FOV: 45 degrees, retinal fundus photograph: 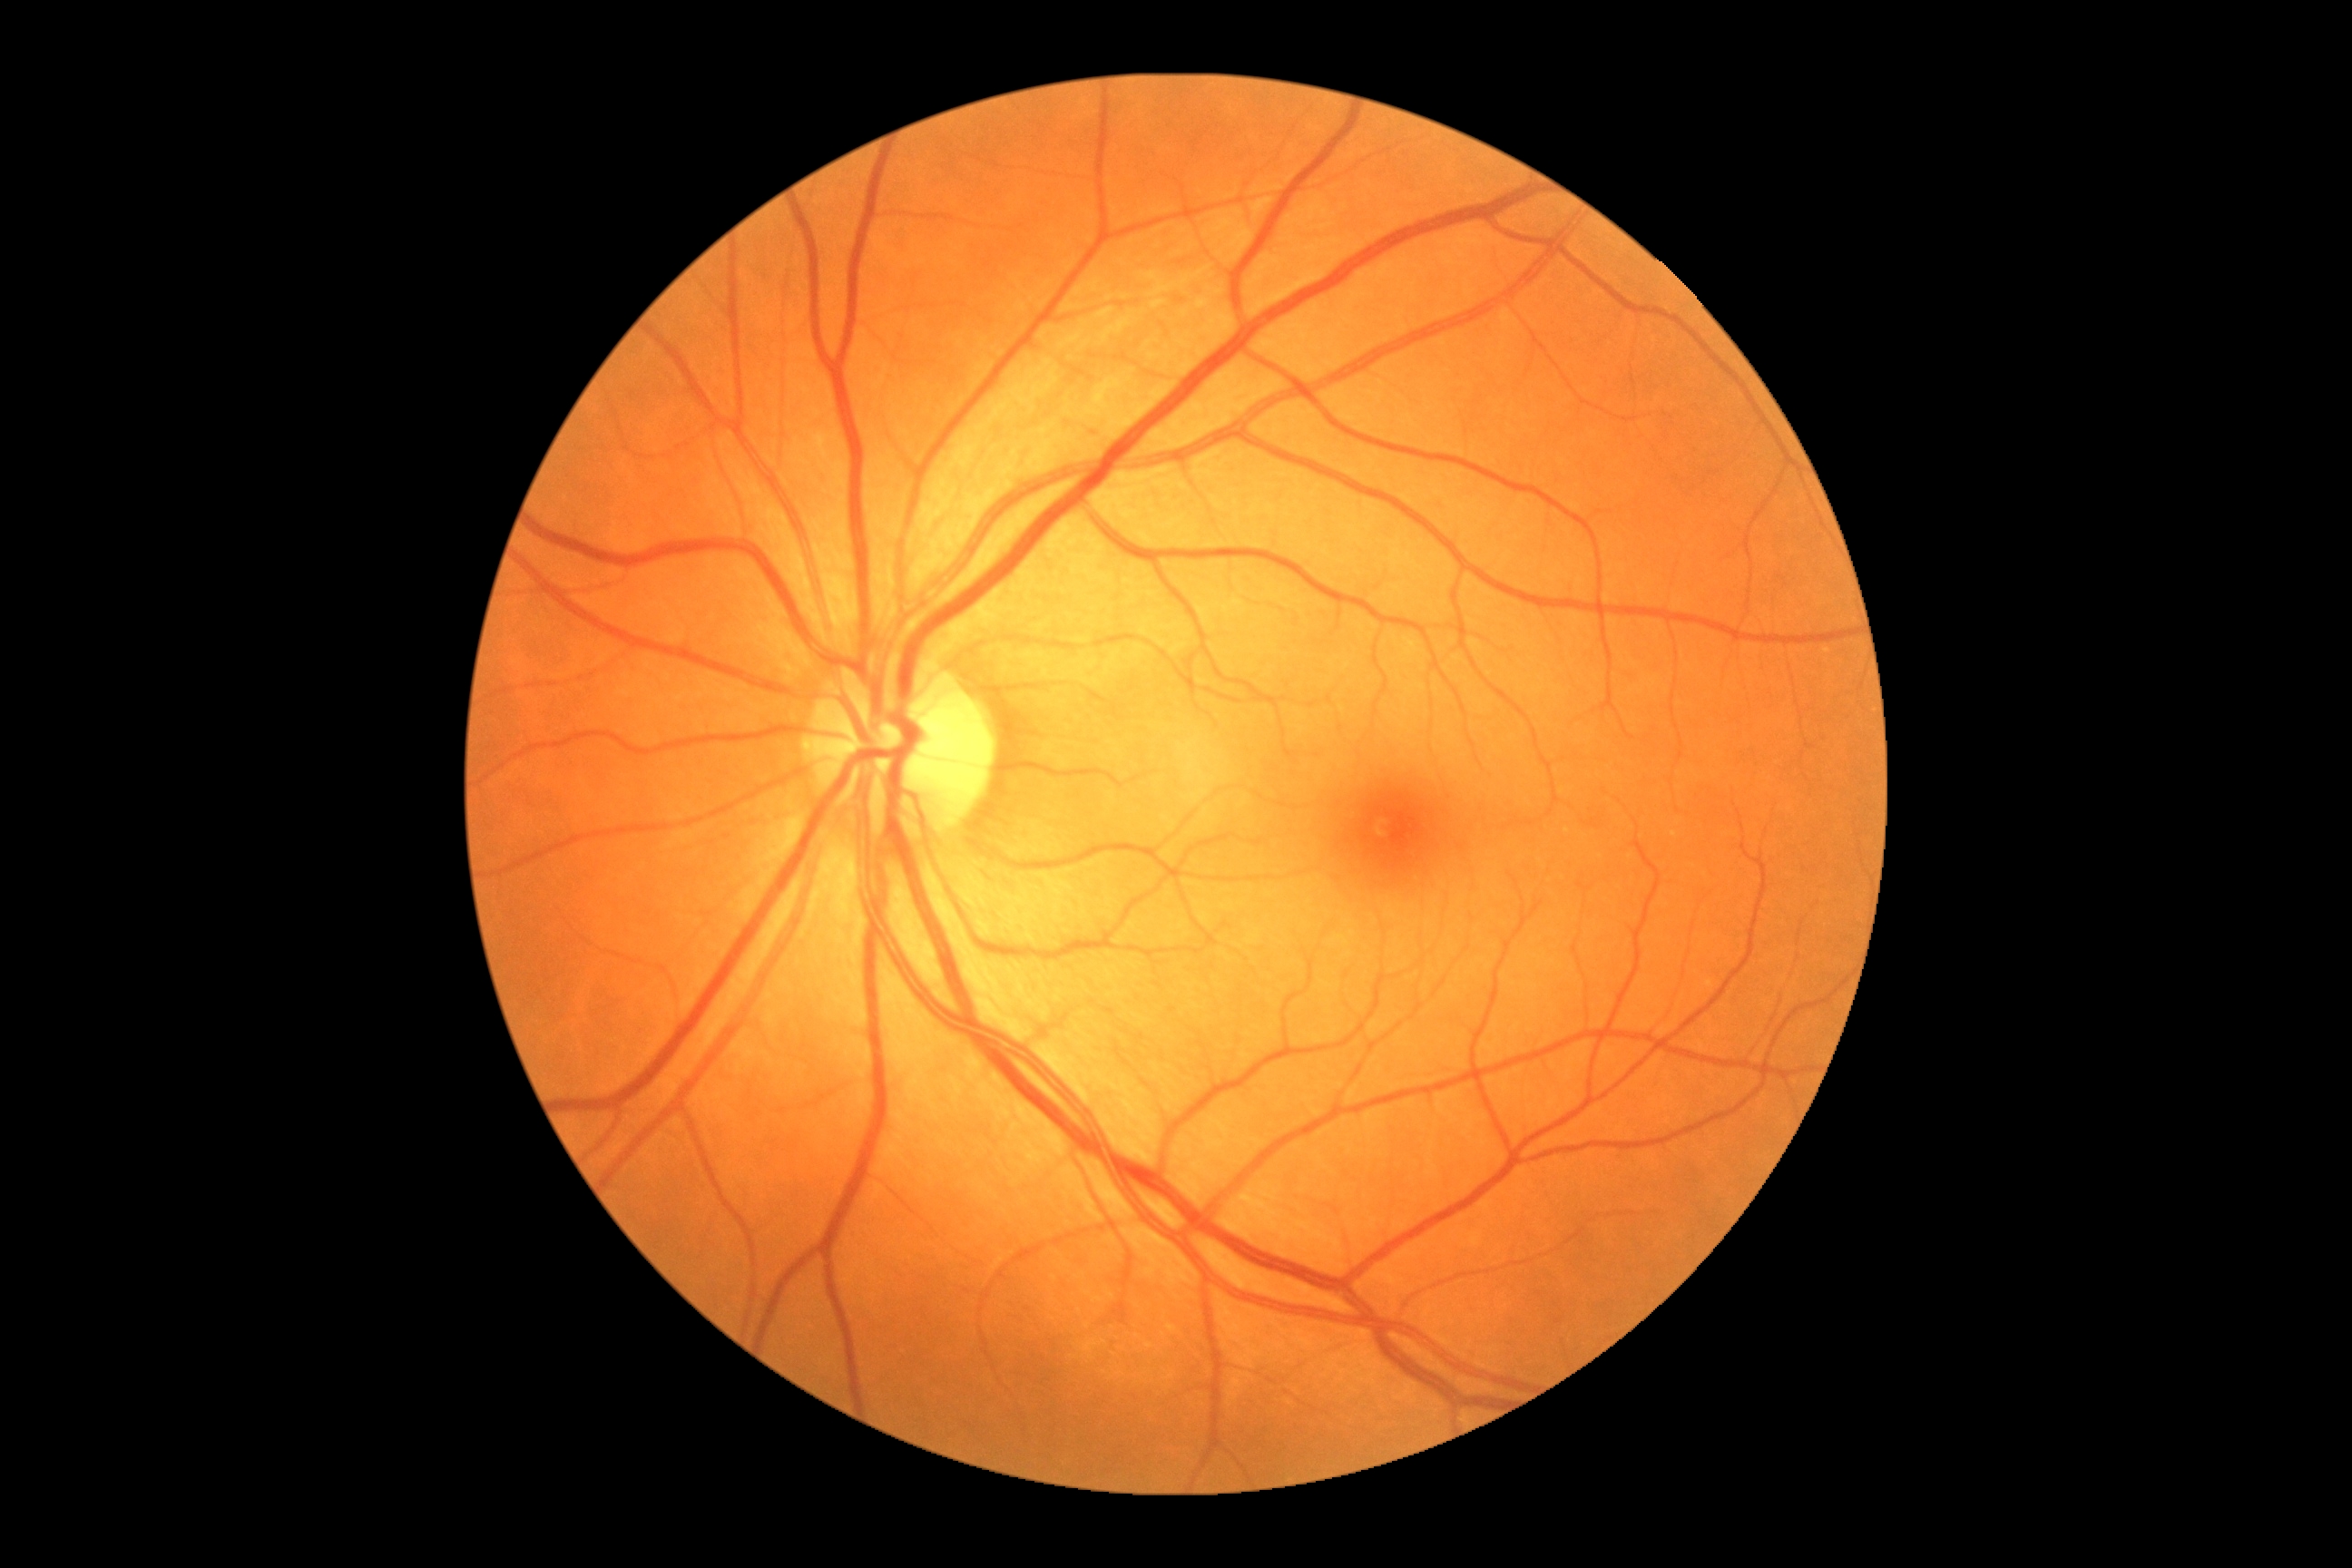
DR = grade 0 (no apparent retinopathy).